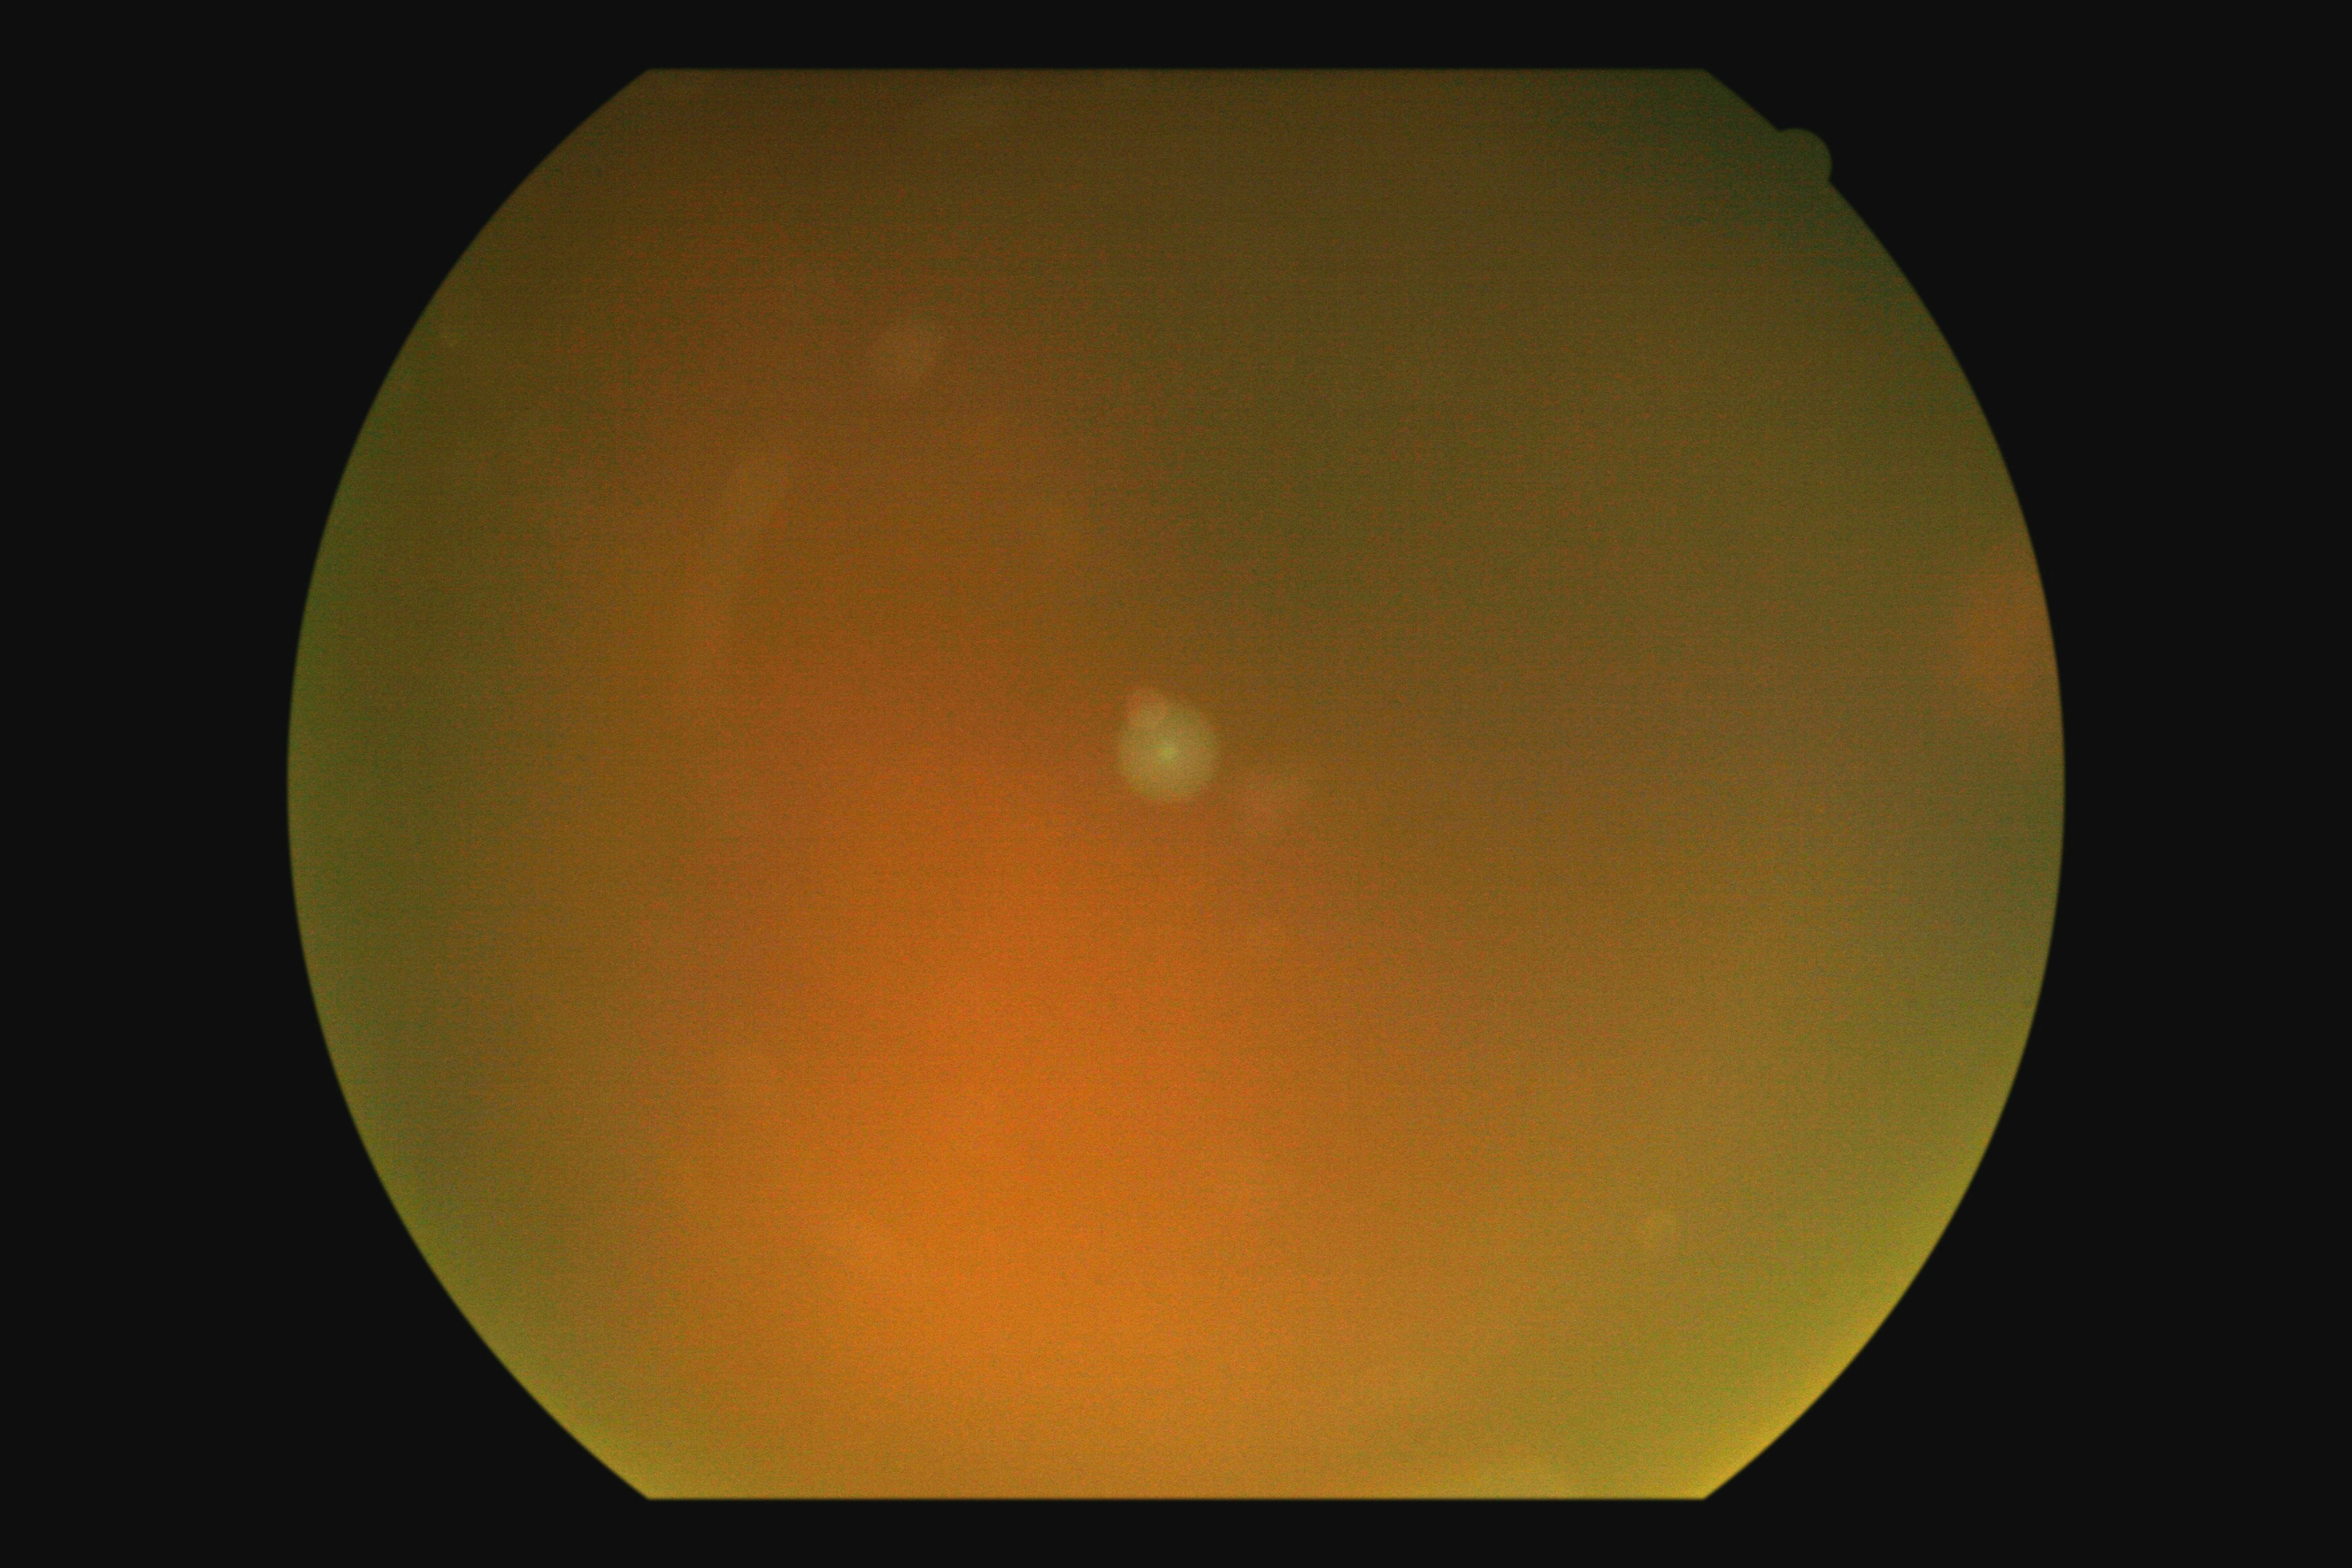
Ungradable image — DR severity cannot be determined. Diabetic retinopathy (DR): ungradable.